Fundus photo
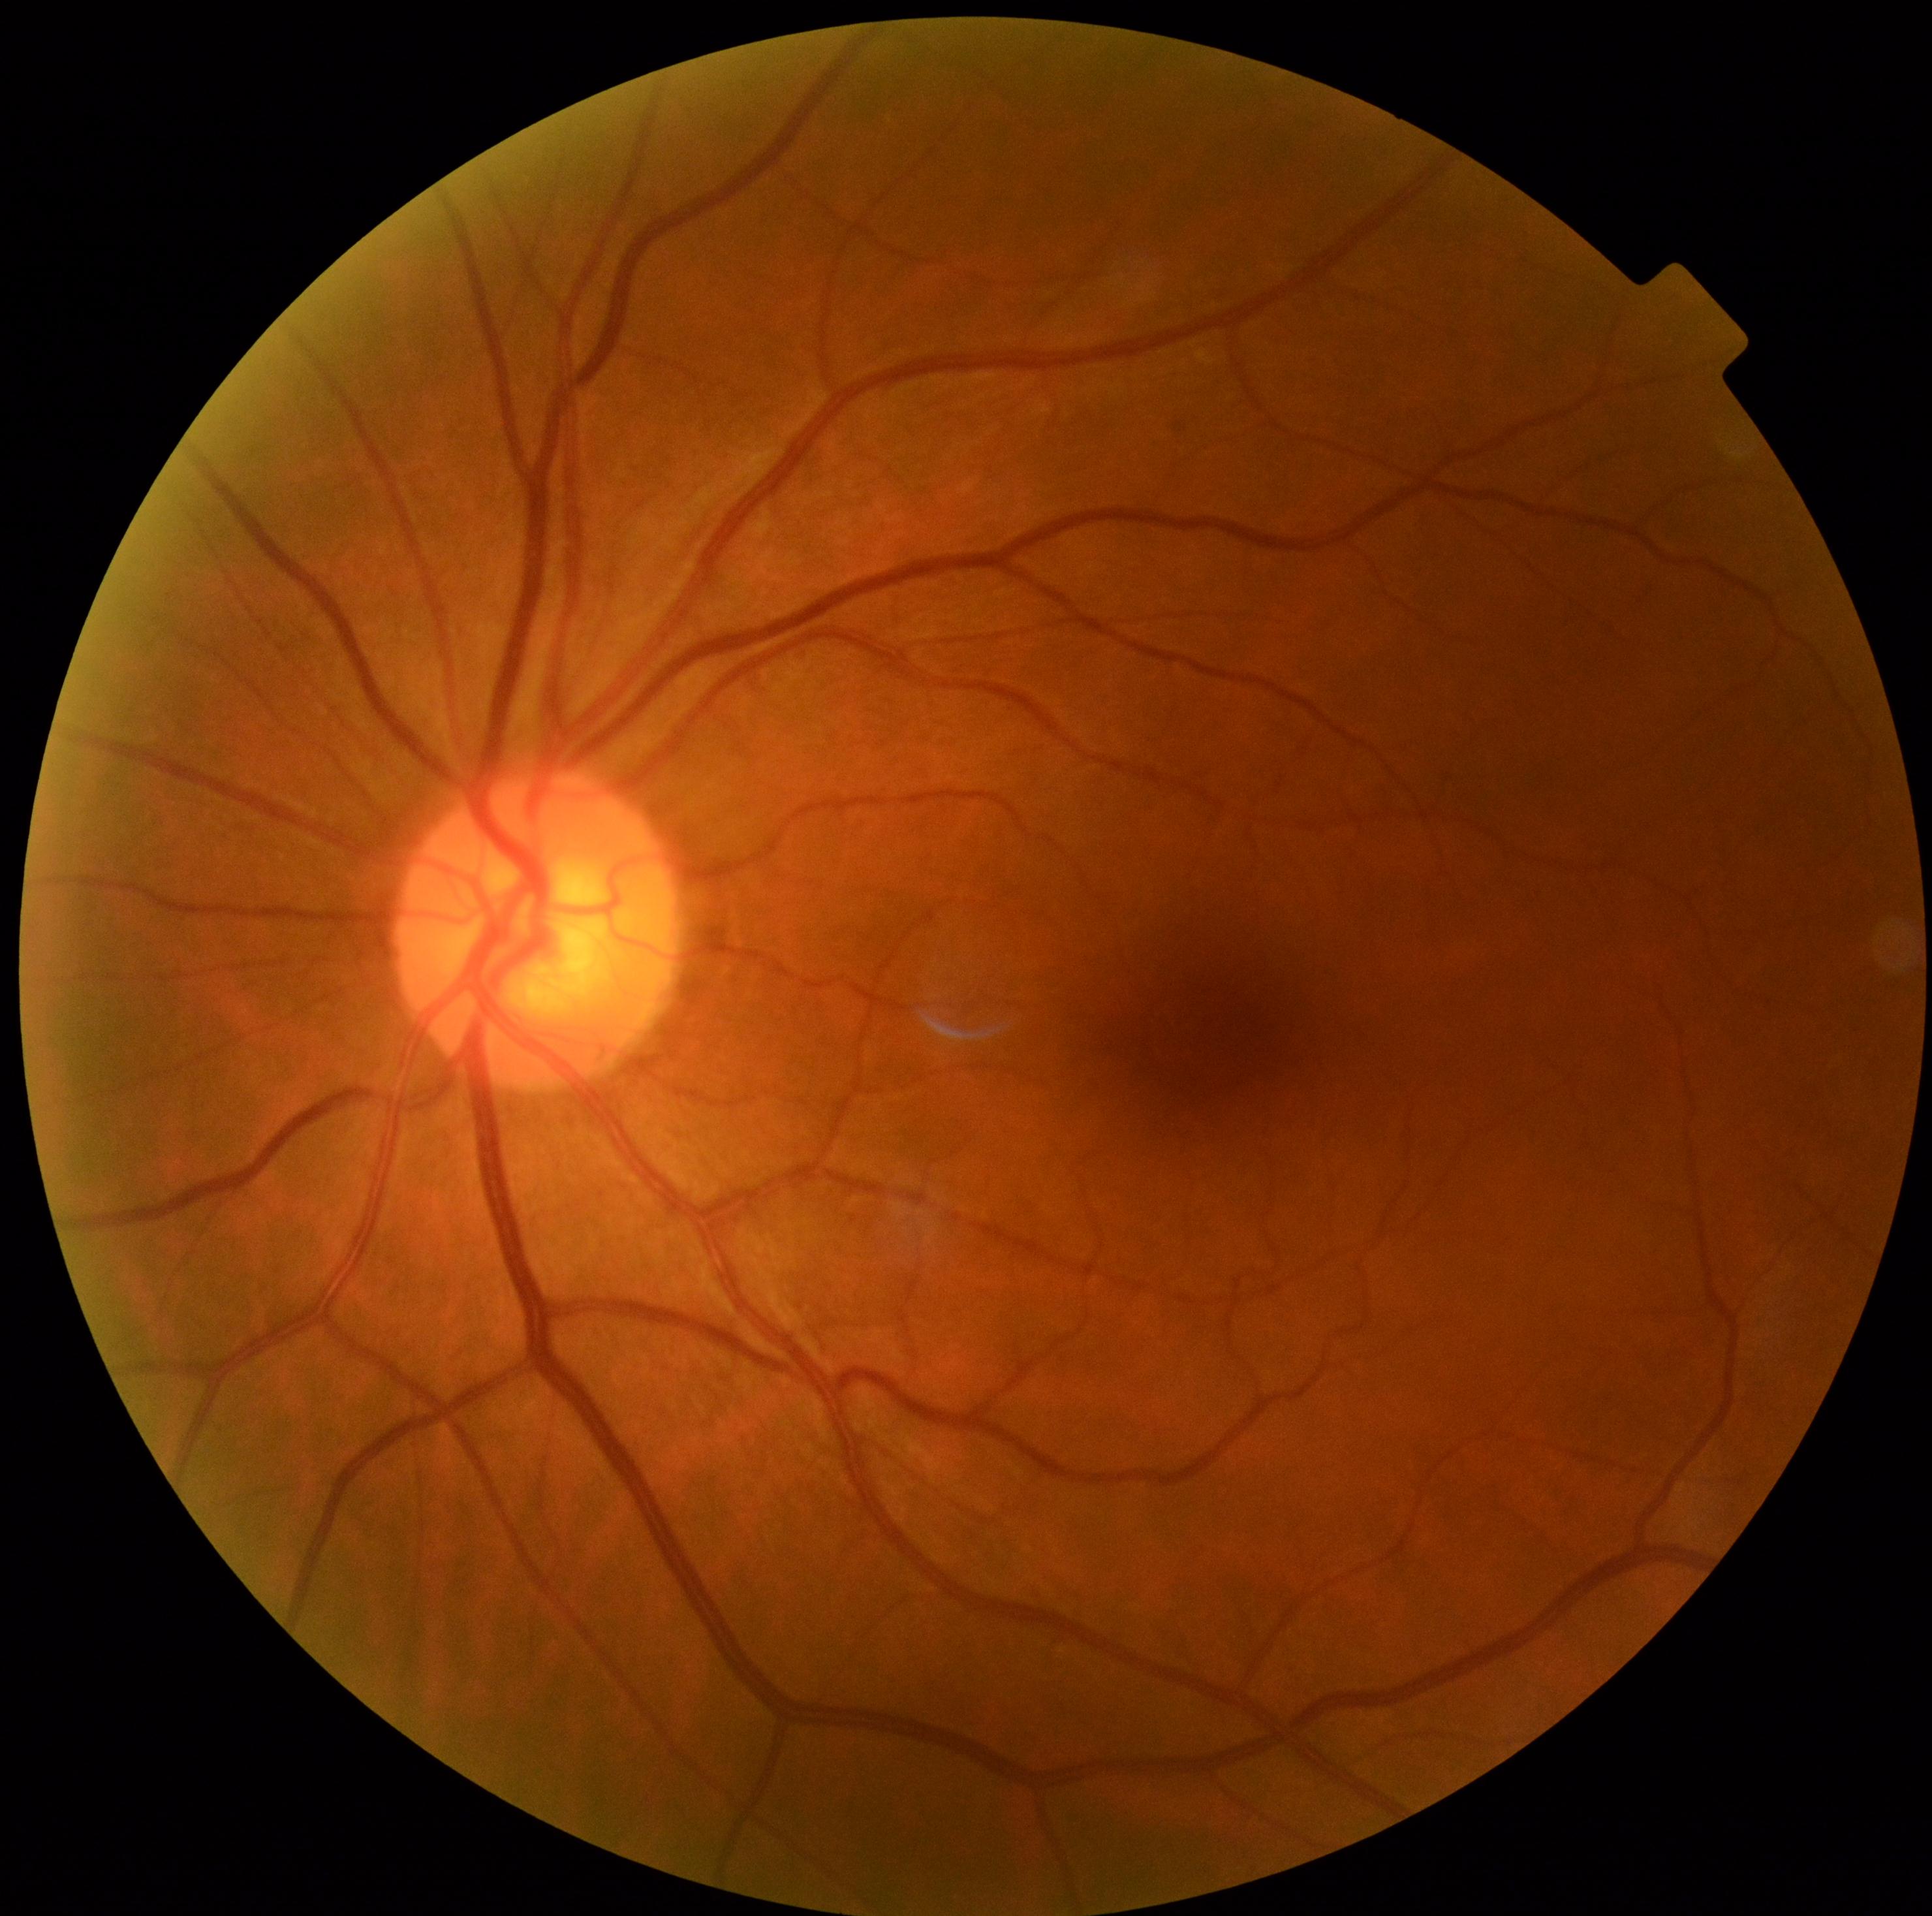 Findings:
– DR impression — negative for DR
– diabetic retinopathy — 0/4